Pediatric wide-field fundus photograph; 640 by 480 pixels; captured with the Clarity RetCam 3 (130° field of view) — 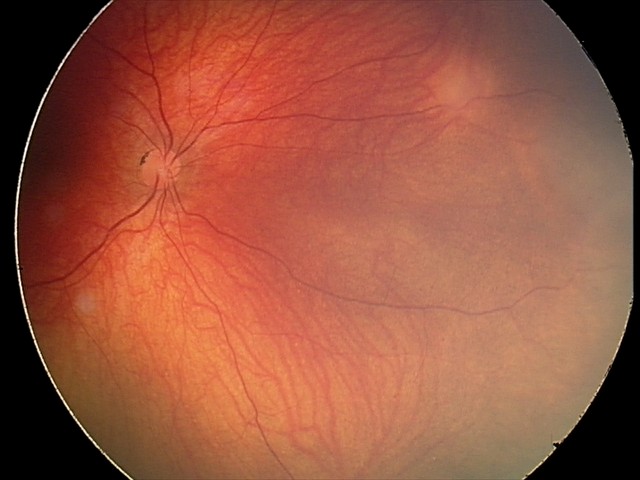

From an examination with diagnosis of retinal astrocytic hamartoma.